Color fundus photograph · pupil-dilated
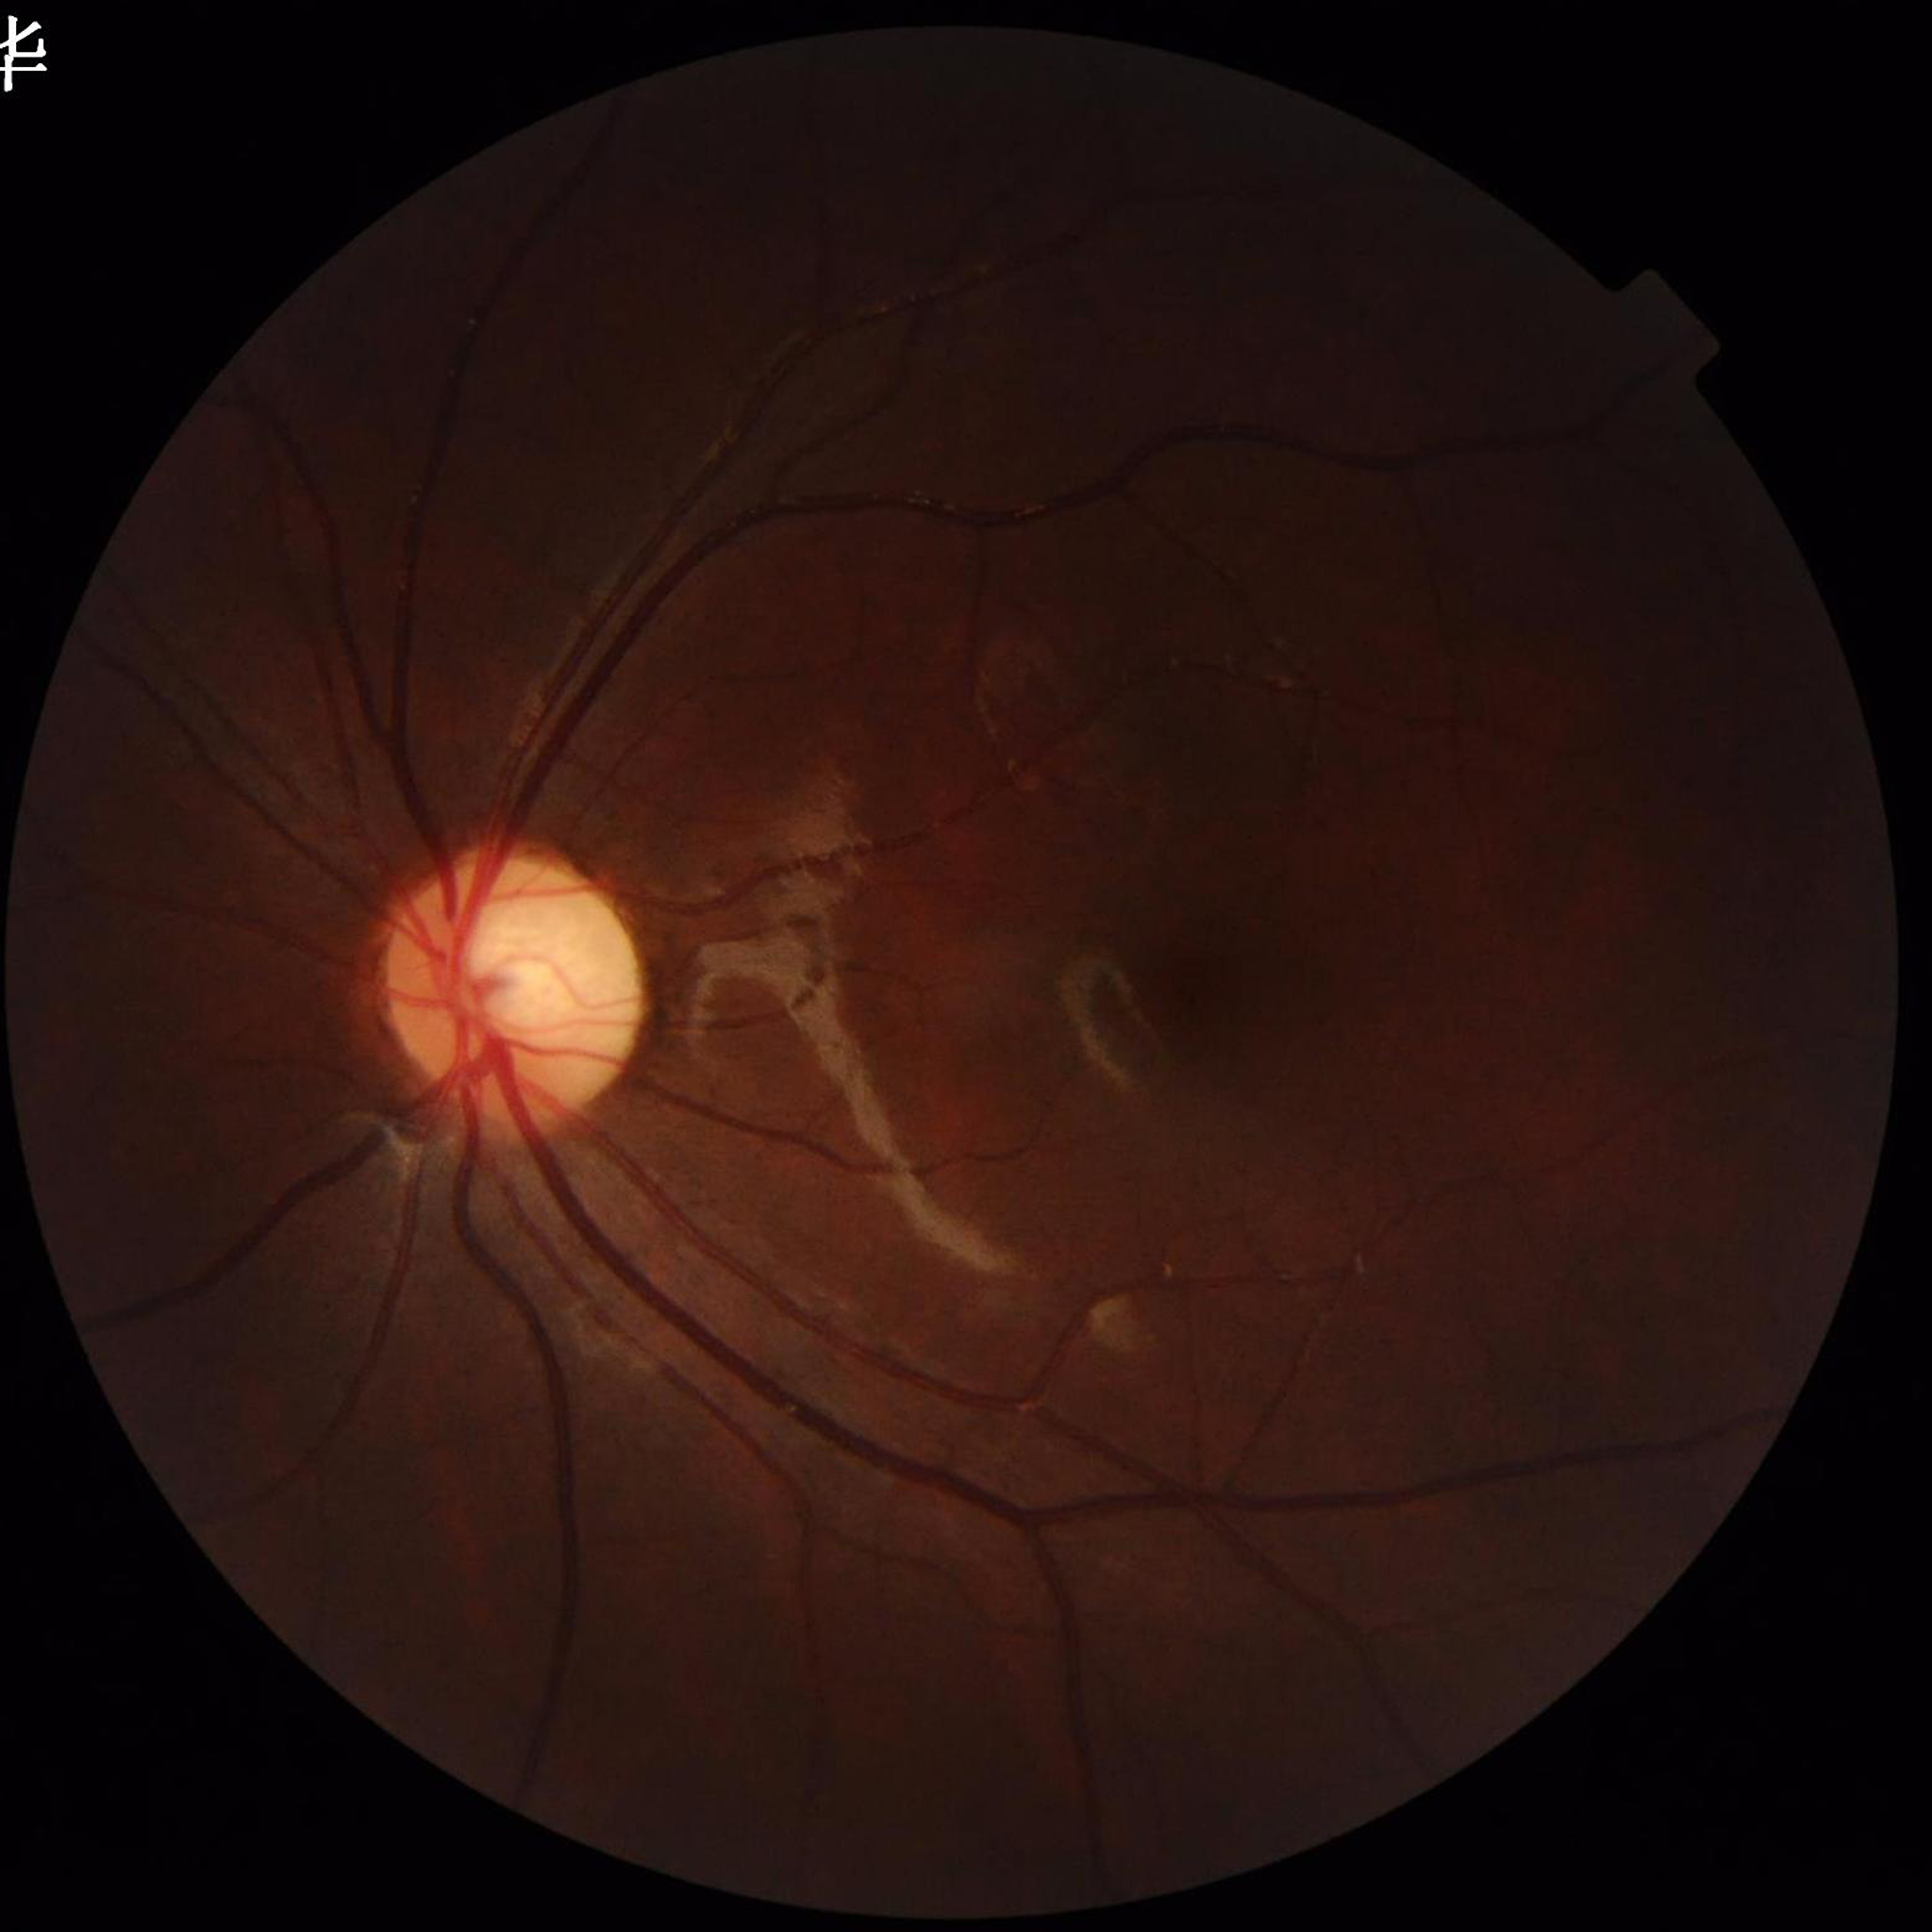 From a control without AMD, diabetic retinopathy, or glaucoma.
Quality: issues noted — illumination/color distortion.